Infant wide-field retinal image — 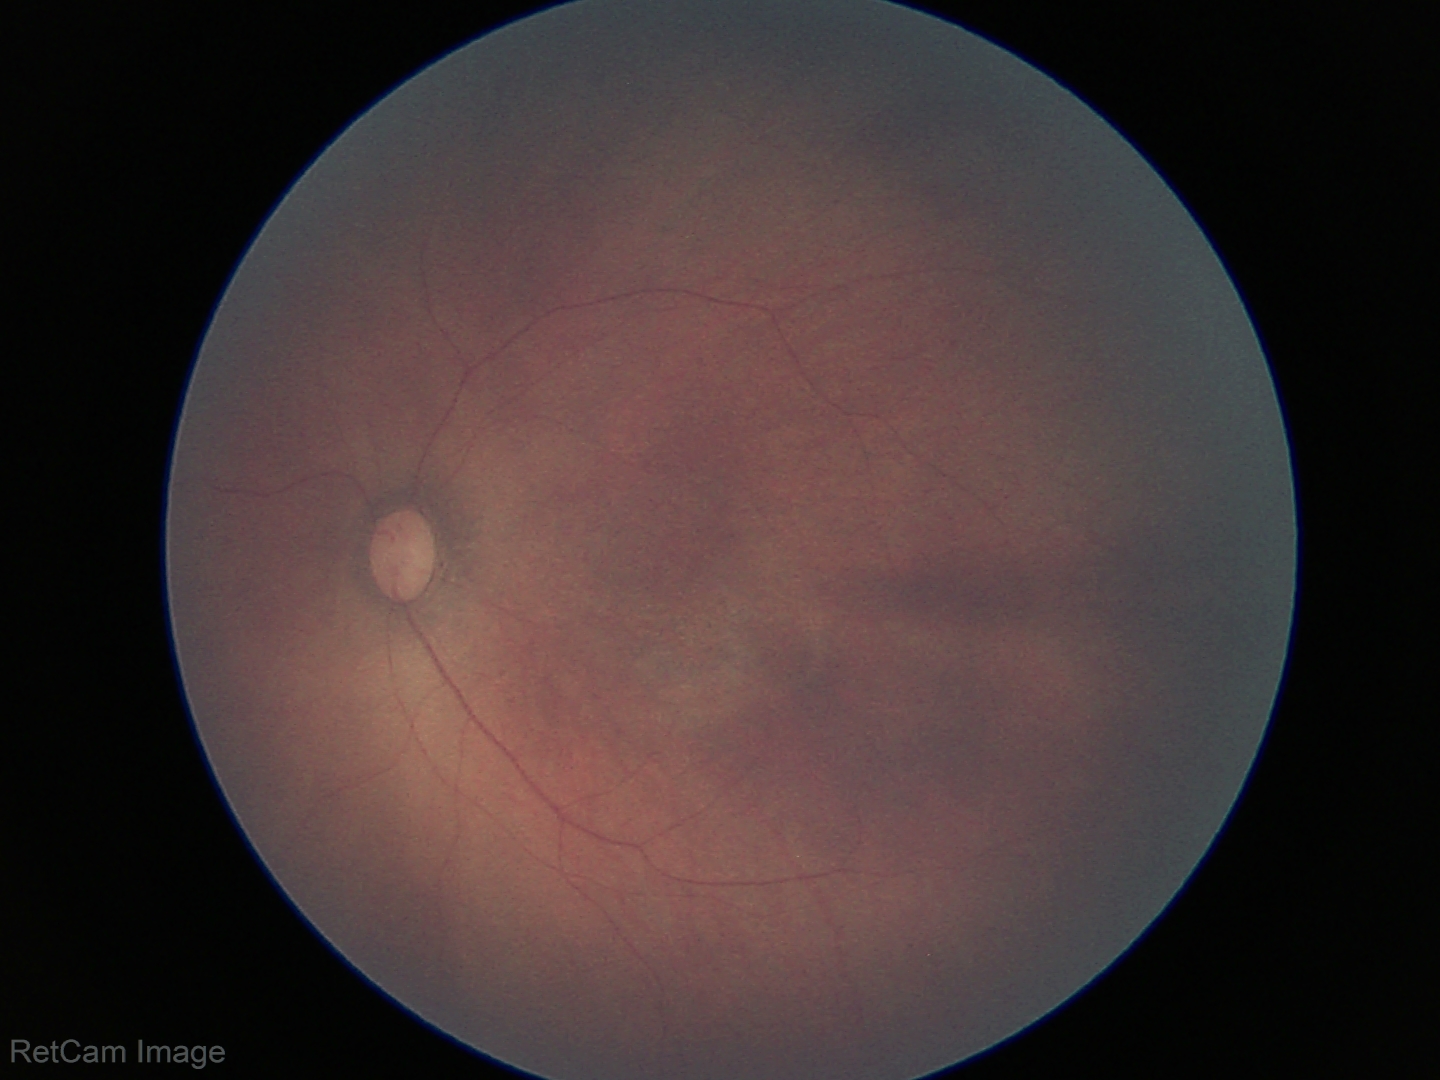
Q: What is the diagnosis from this examination?
A: no abnormal retinal findings